2212x1659px.
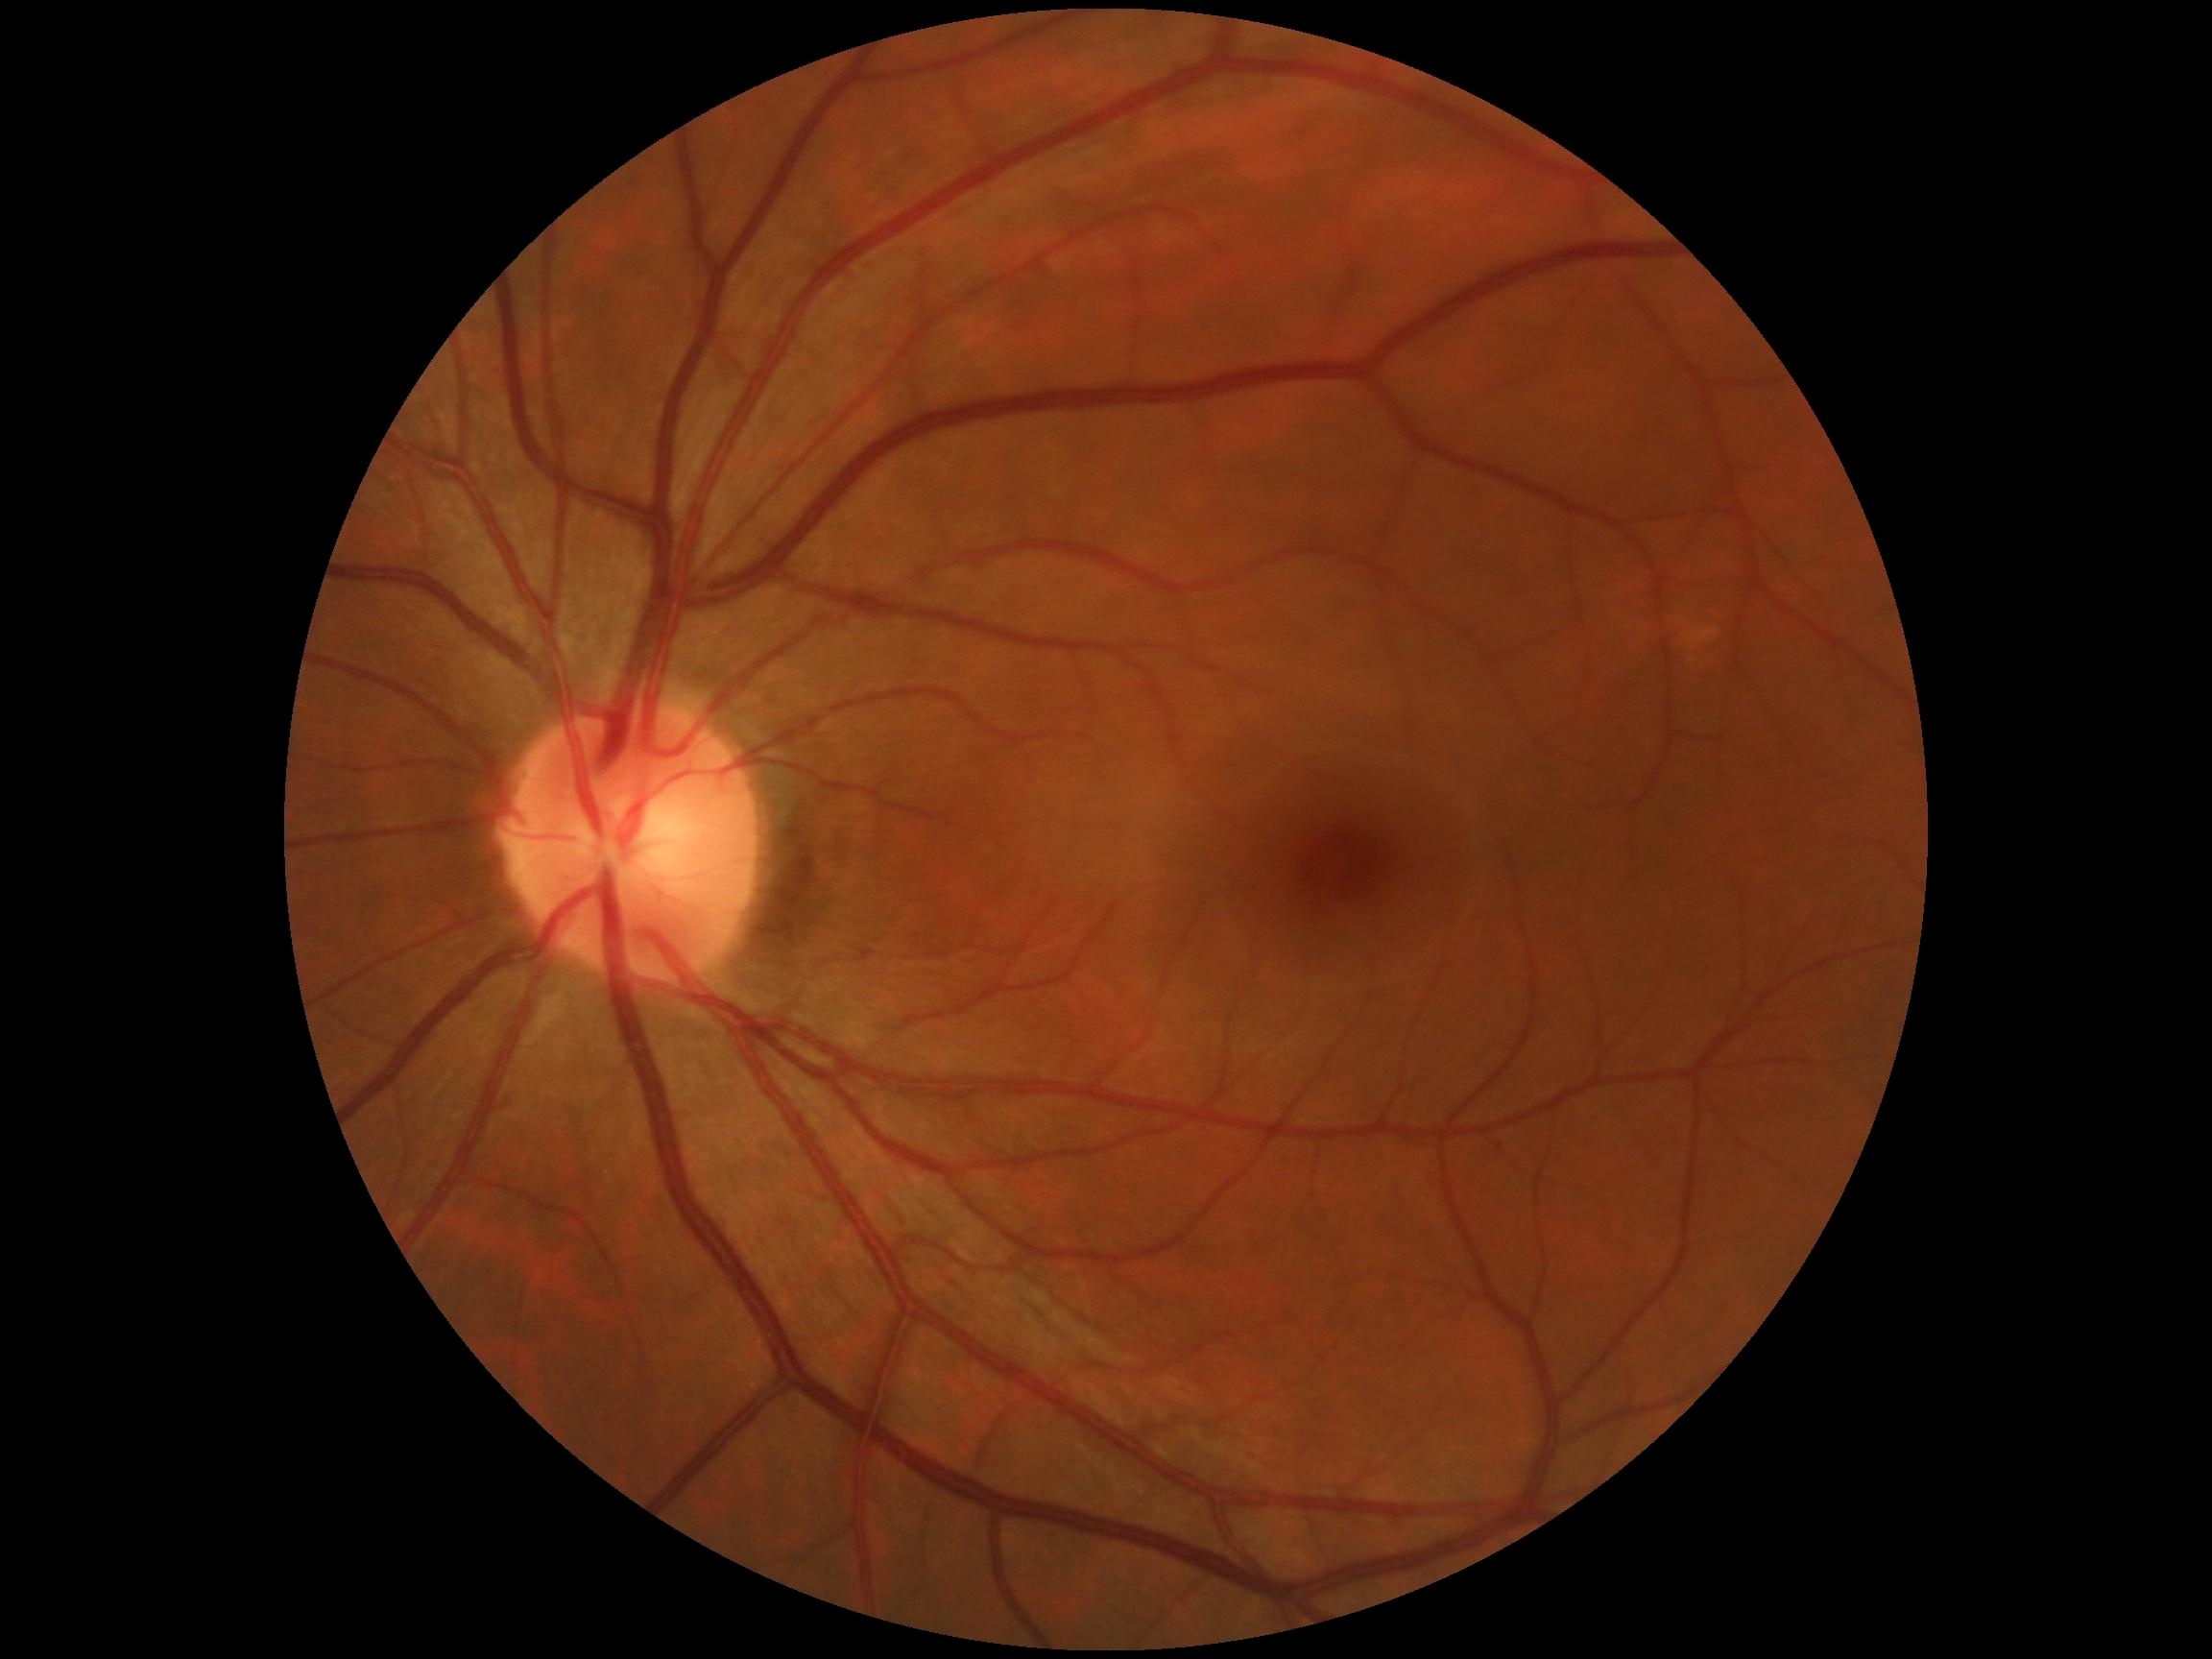
DR impression@no signs of DR, retinopathy@no apparent diabetic retinopathy (grade 0).